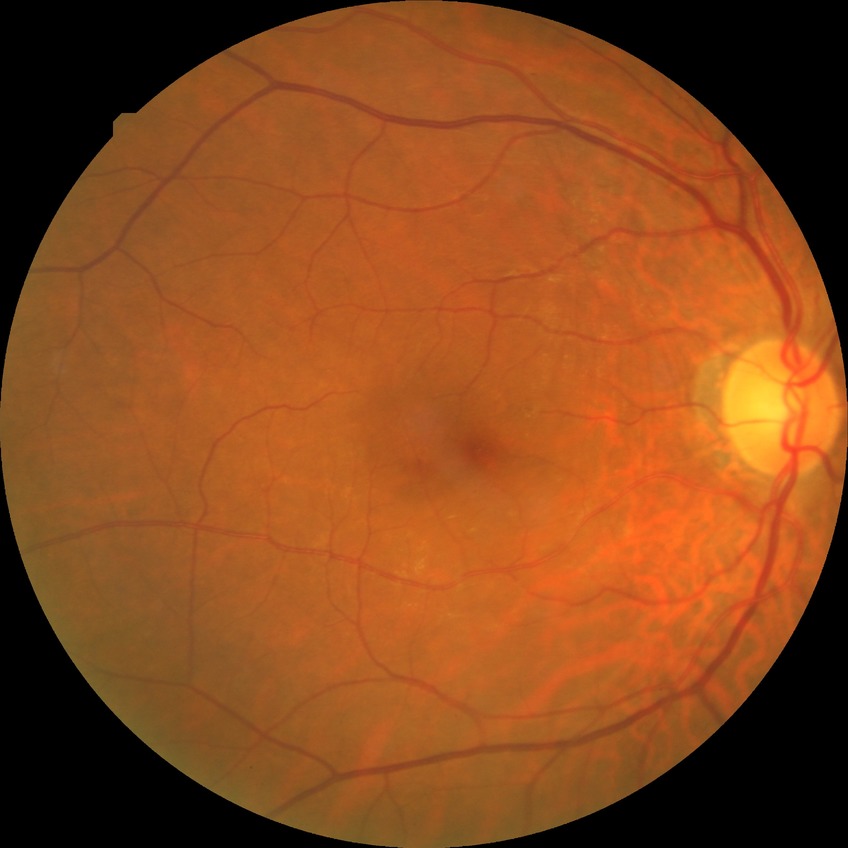
Diabetic retinopathy (DR) is no diabetic retinopathy (NDR).